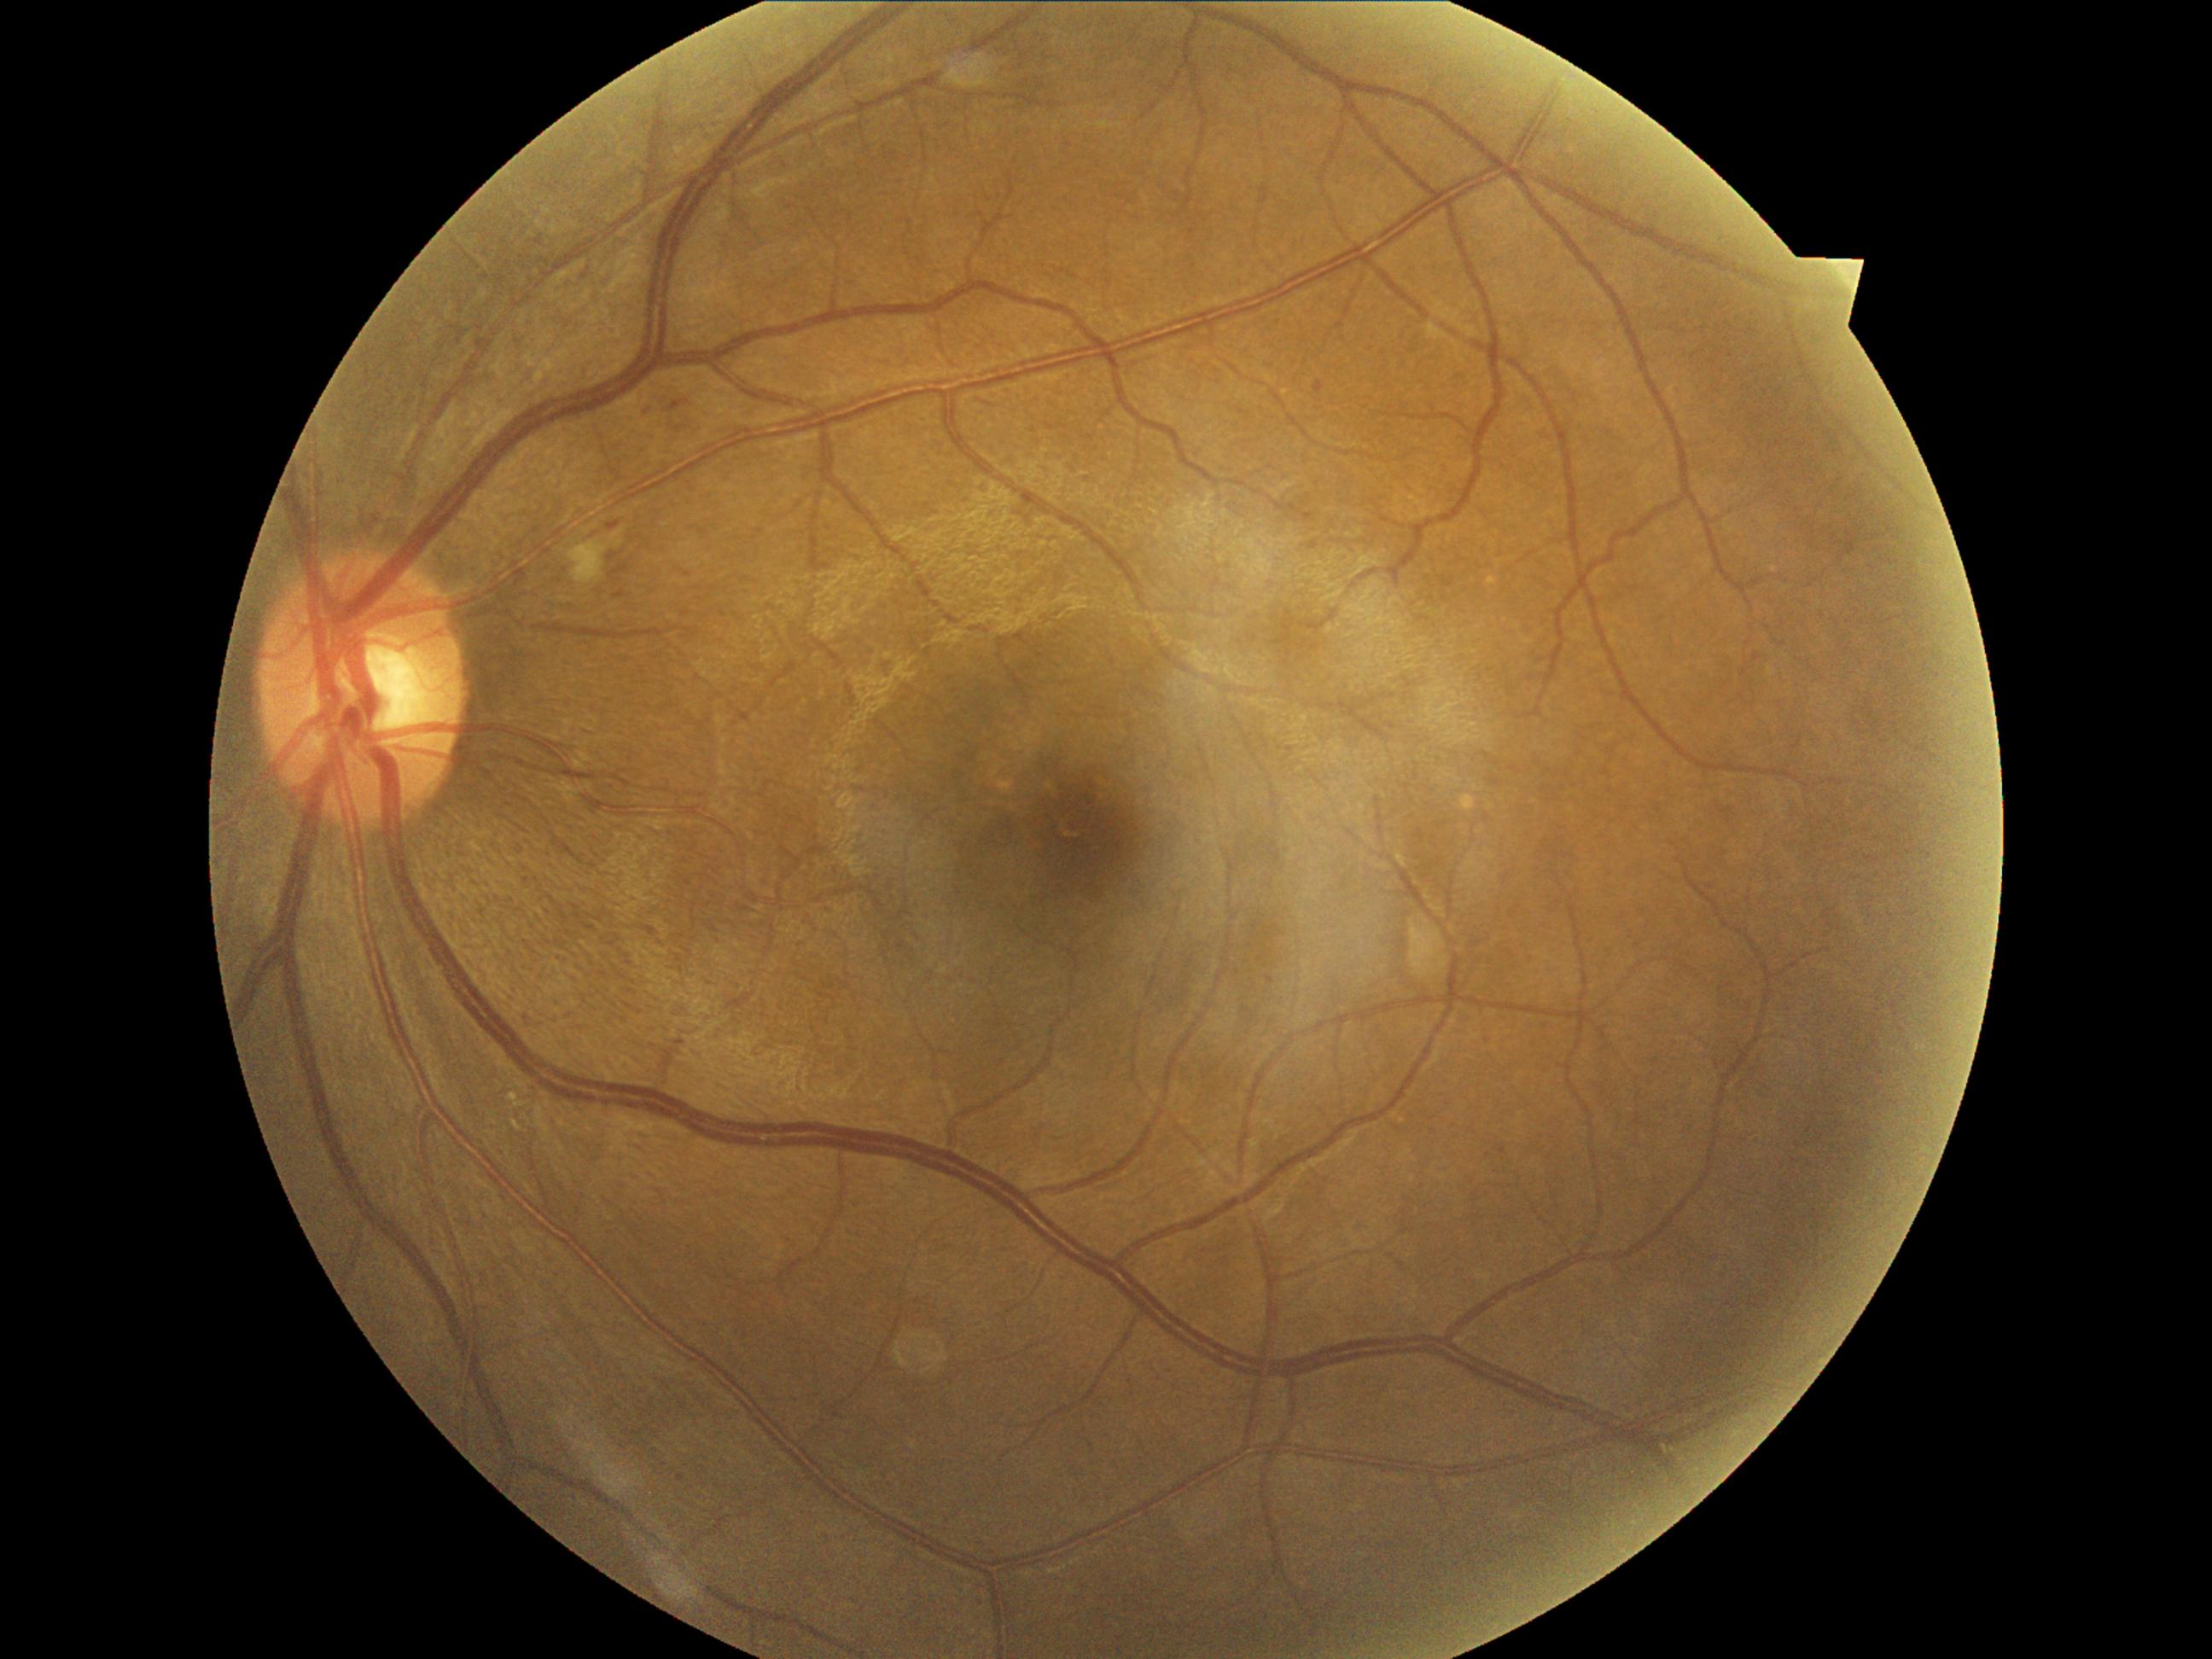

{"dr_grade": "2"}